640 x 480 pixels. Infant wide-field retinal image: 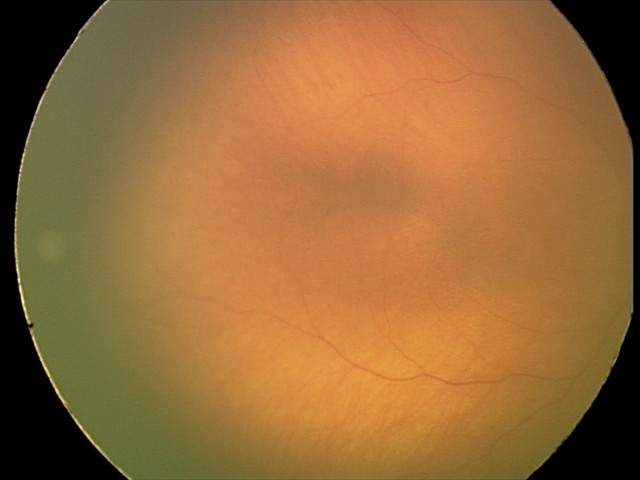

Normal screening examination.